Pediatric wide-field fundus photograph · 640x480px · acquired on the Clarity RetCam 3.
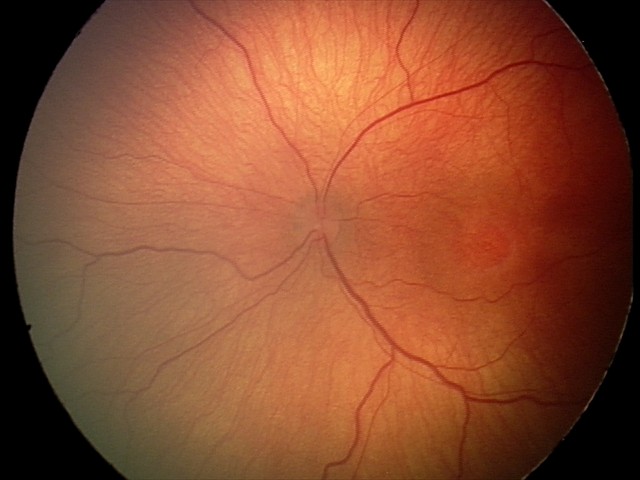 Q: What is the diagnosis from this examination?
A: retinopathy of prematurity (ROP) stage 2